Optic nerve head photograph. 964x964px. FOV 35° before cropping:
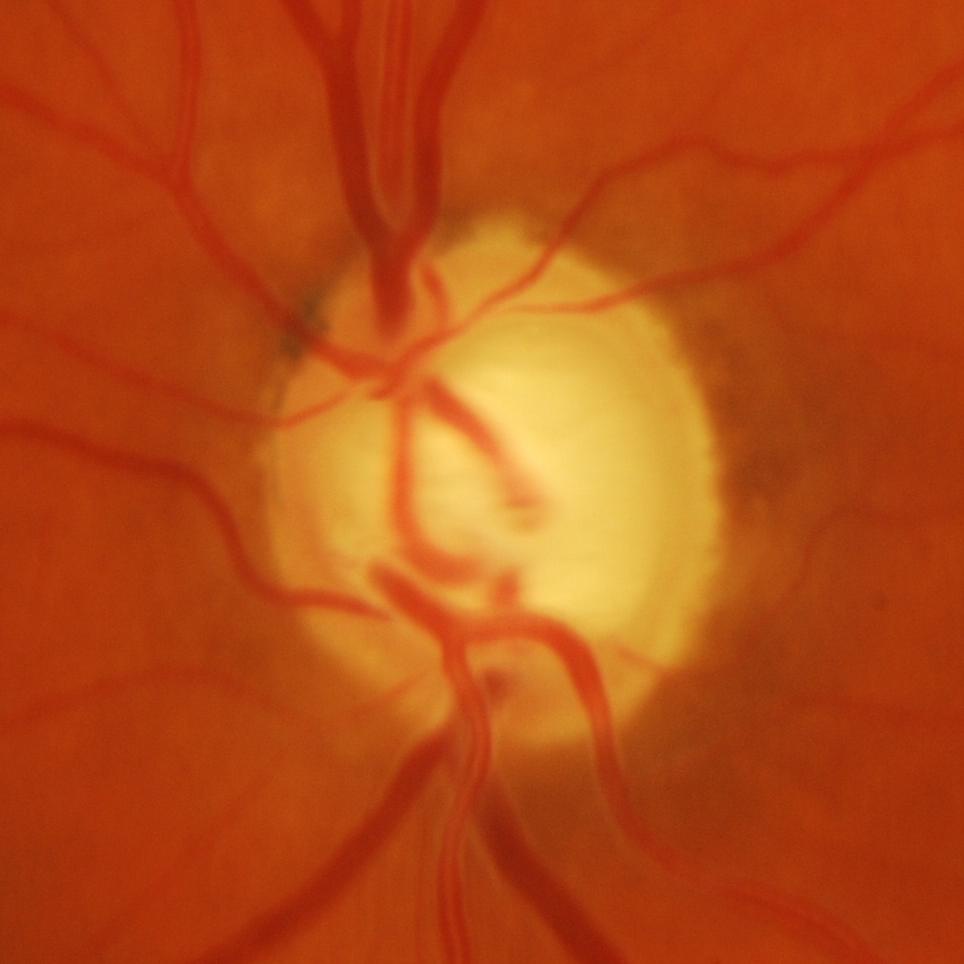 Glaucomatous changes are present. Diagnosis: evidence of glaucoma.